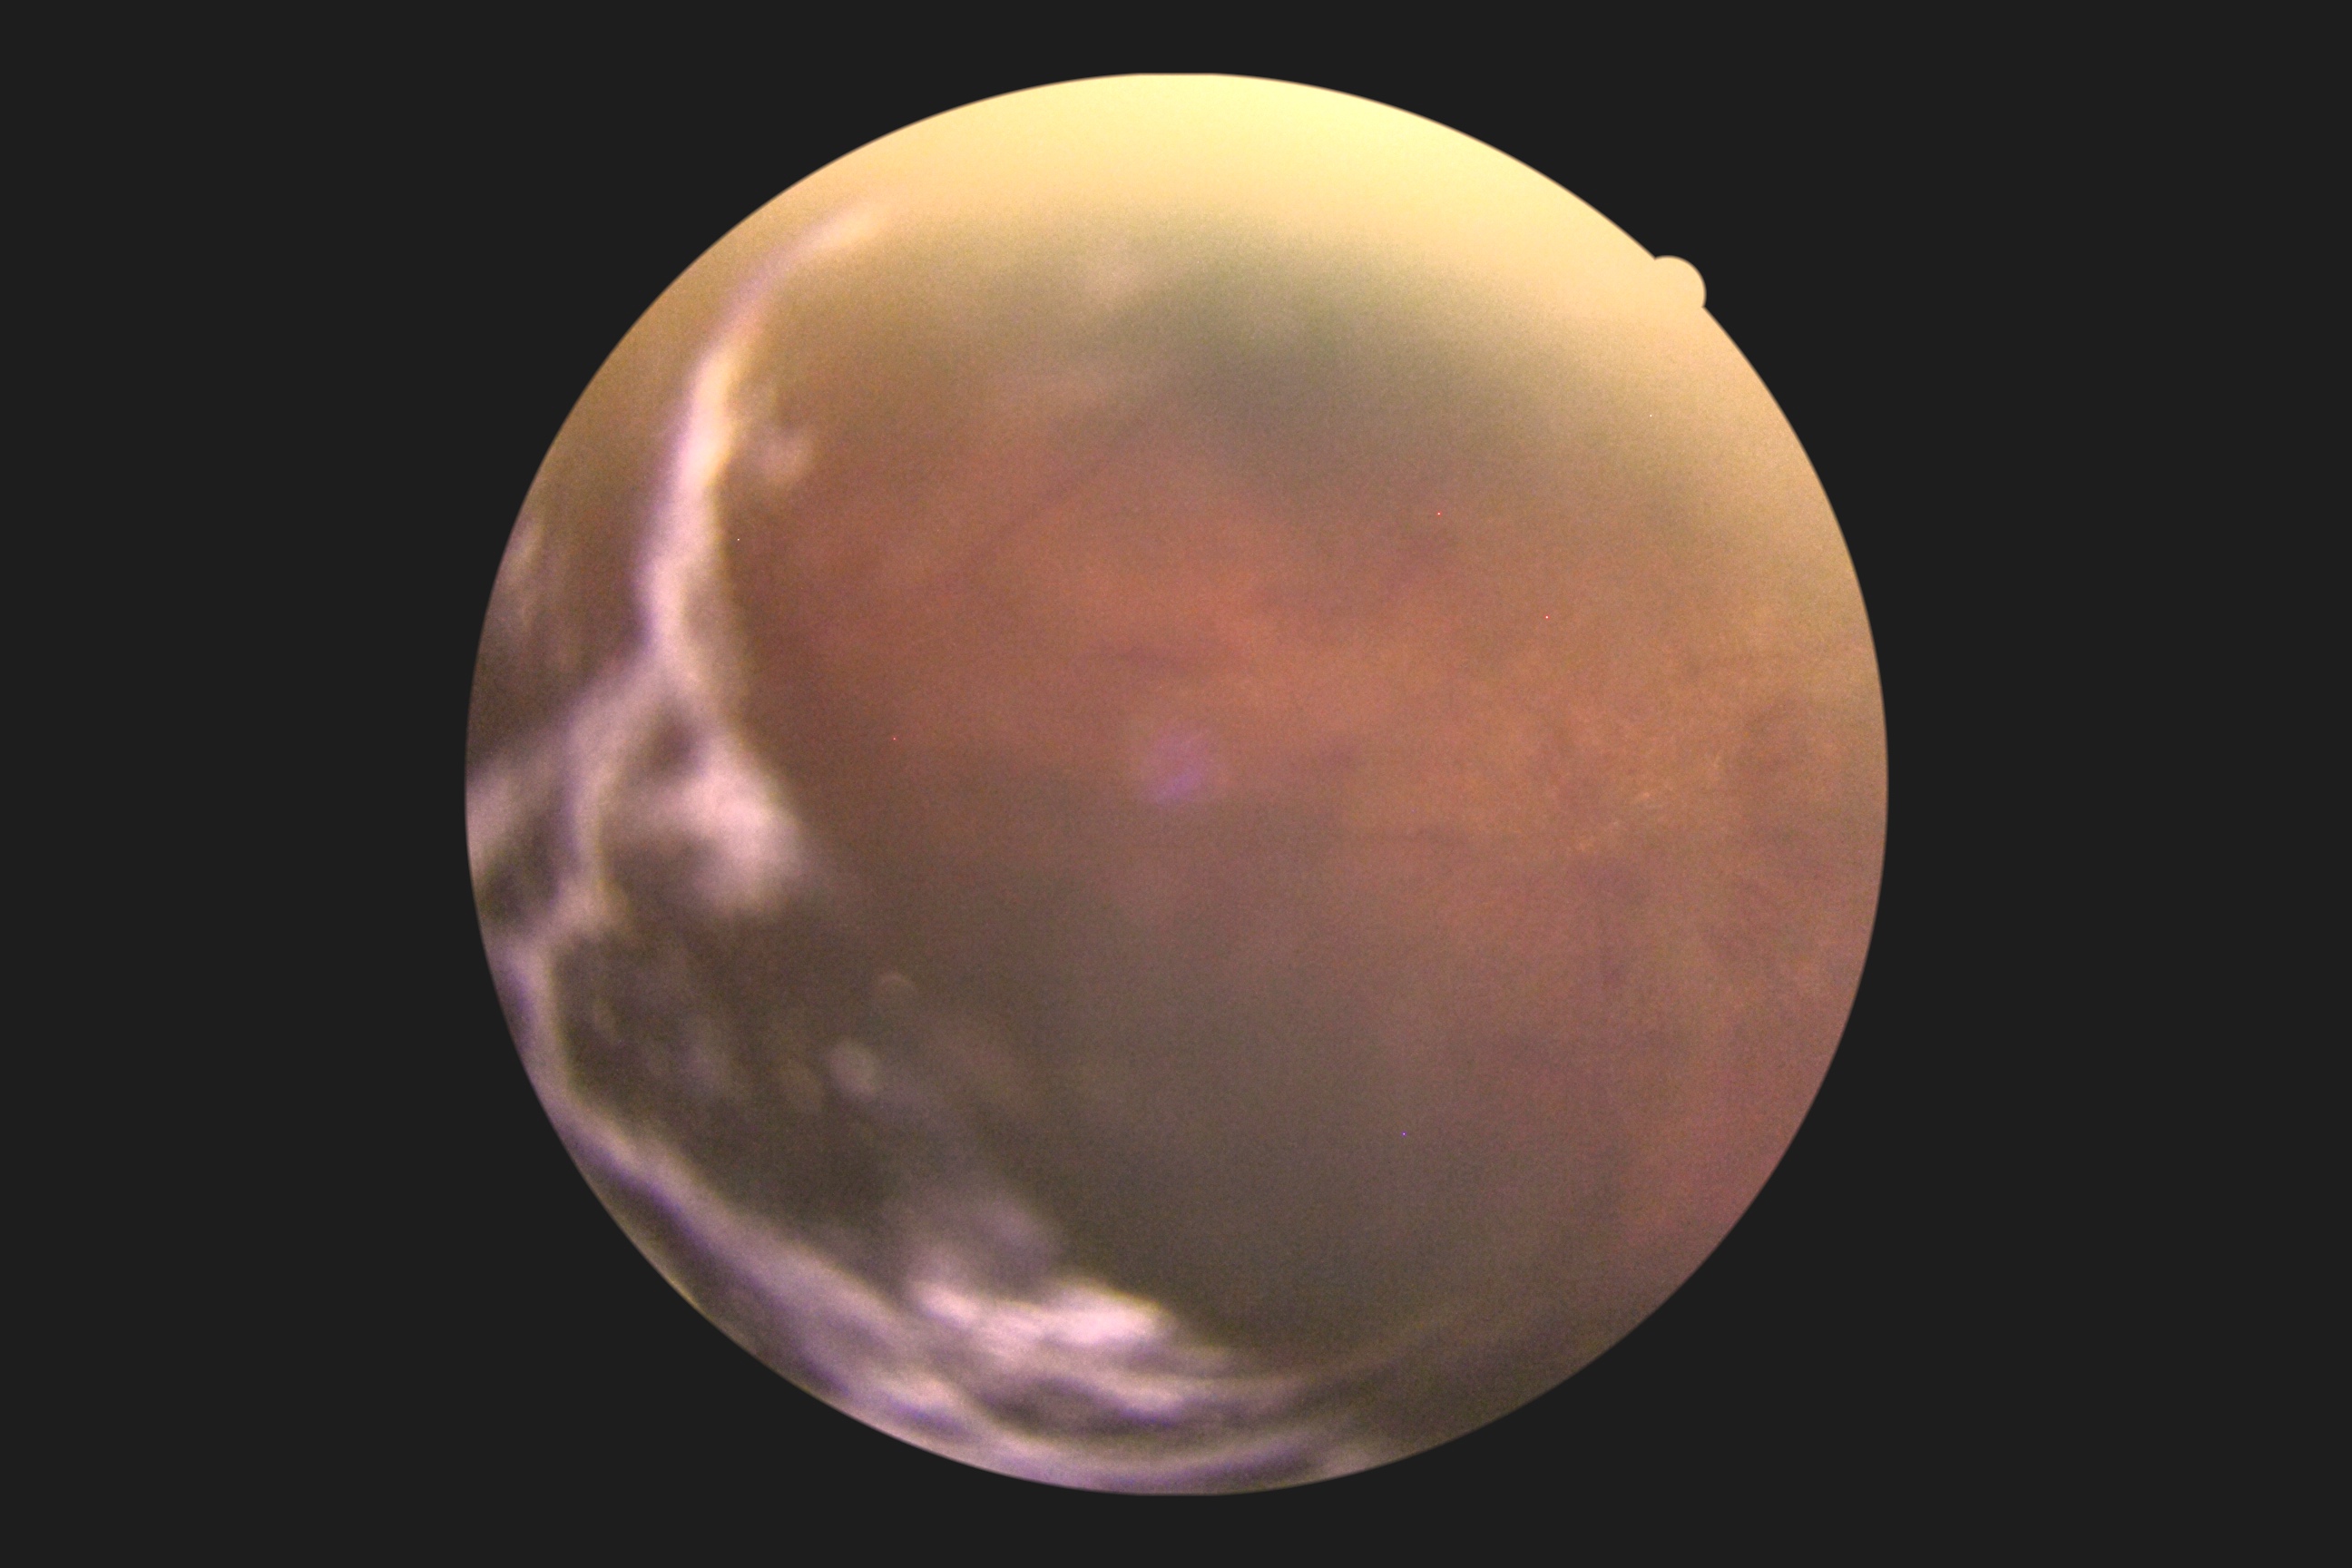

DR: grade 2 (moderate NPDR) — more than just microaneurysms but less than severe NPDR. DR class: non-proliferative diabetic retinopathy.